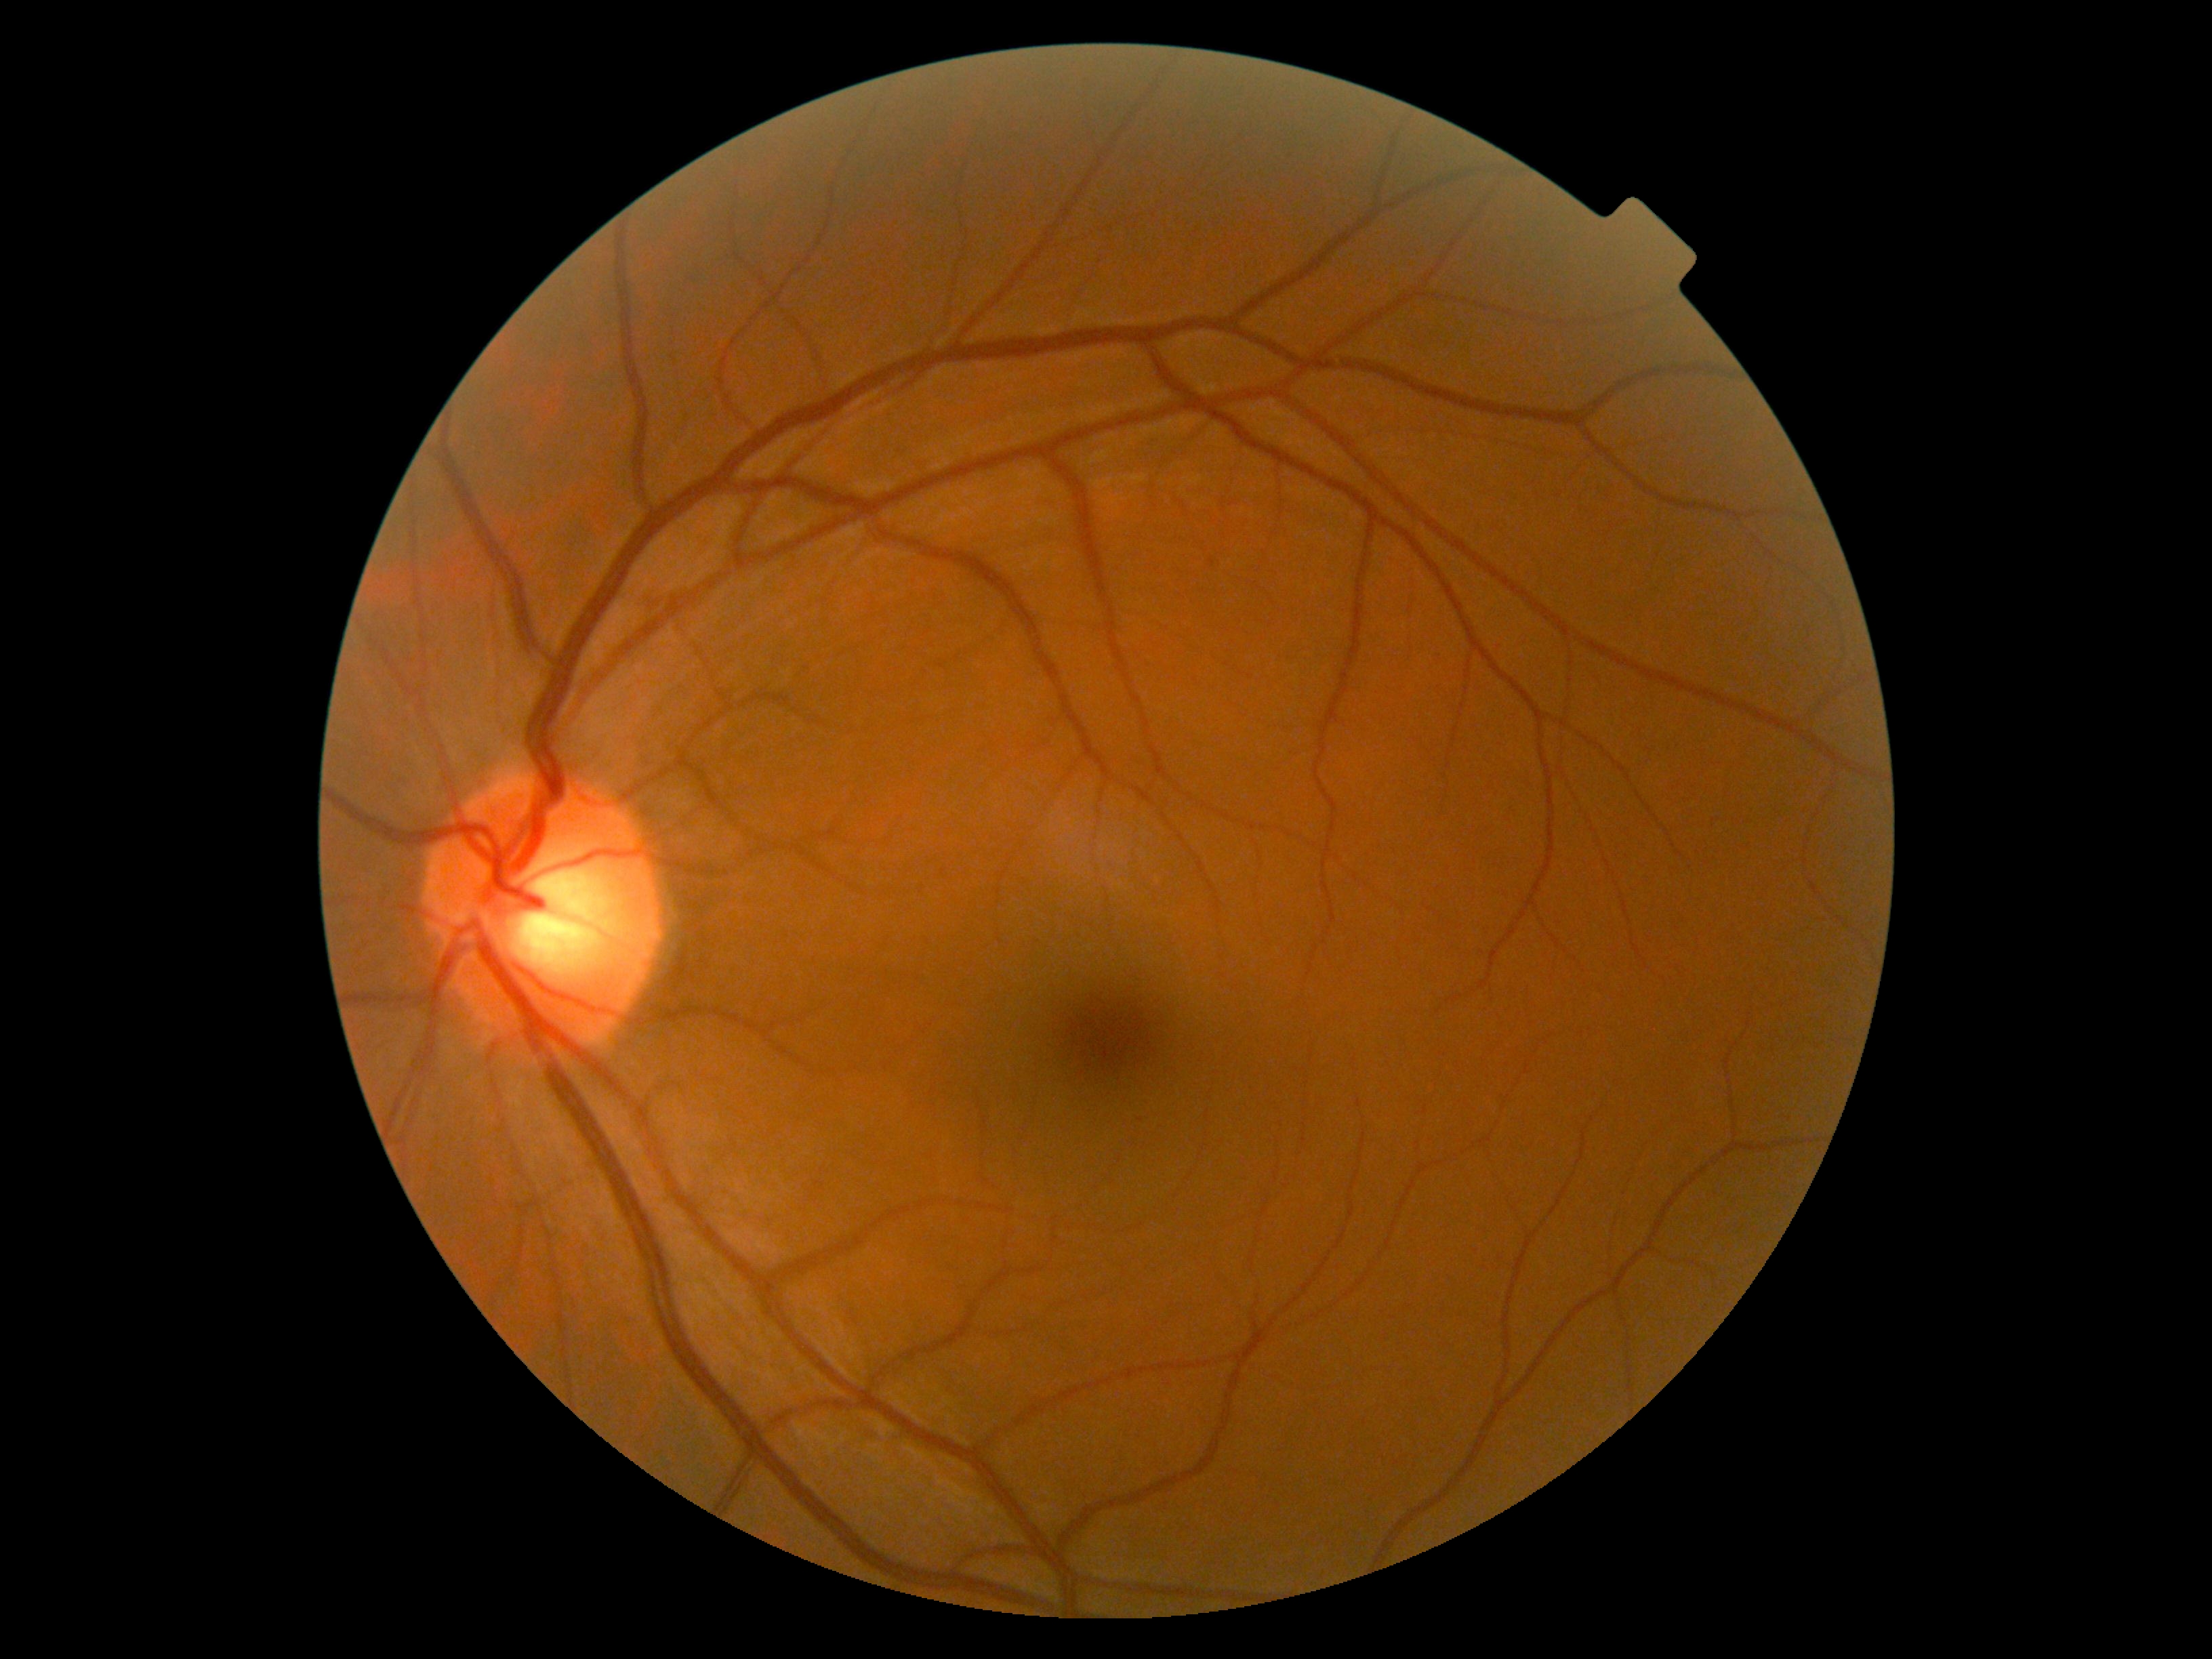
DR stage: grade 0 (no apparent retinopathy).